Wide-field fundus image from infant ROP screening
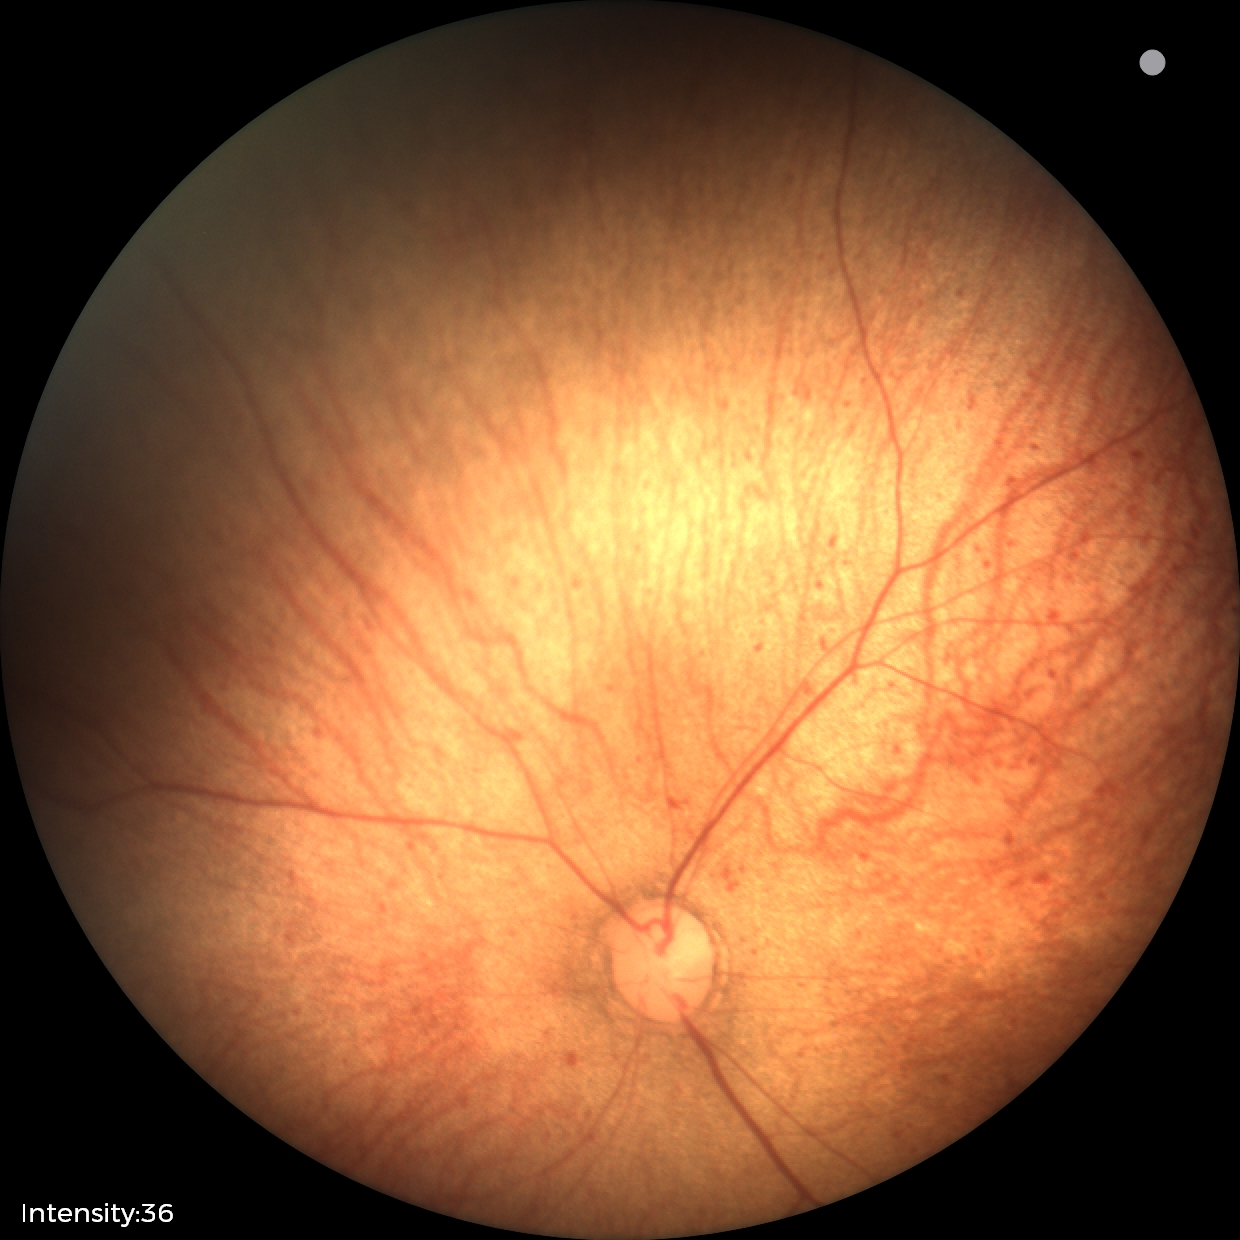 No retinal pathology identified on screening.